Posterior pole color fundus photograph, 848x848px, camera: NIDEK AFC-230, 45-degree field of view
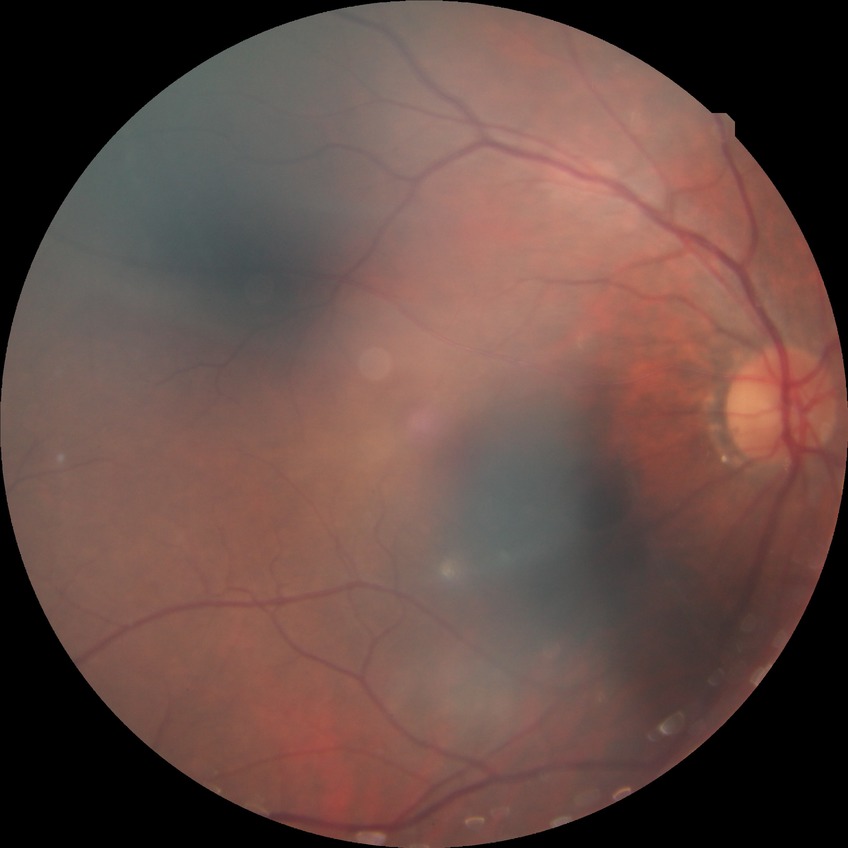

Diabetic retinopathy (DR) is NDR (no diabetic retinopathy).